2212x1672px — 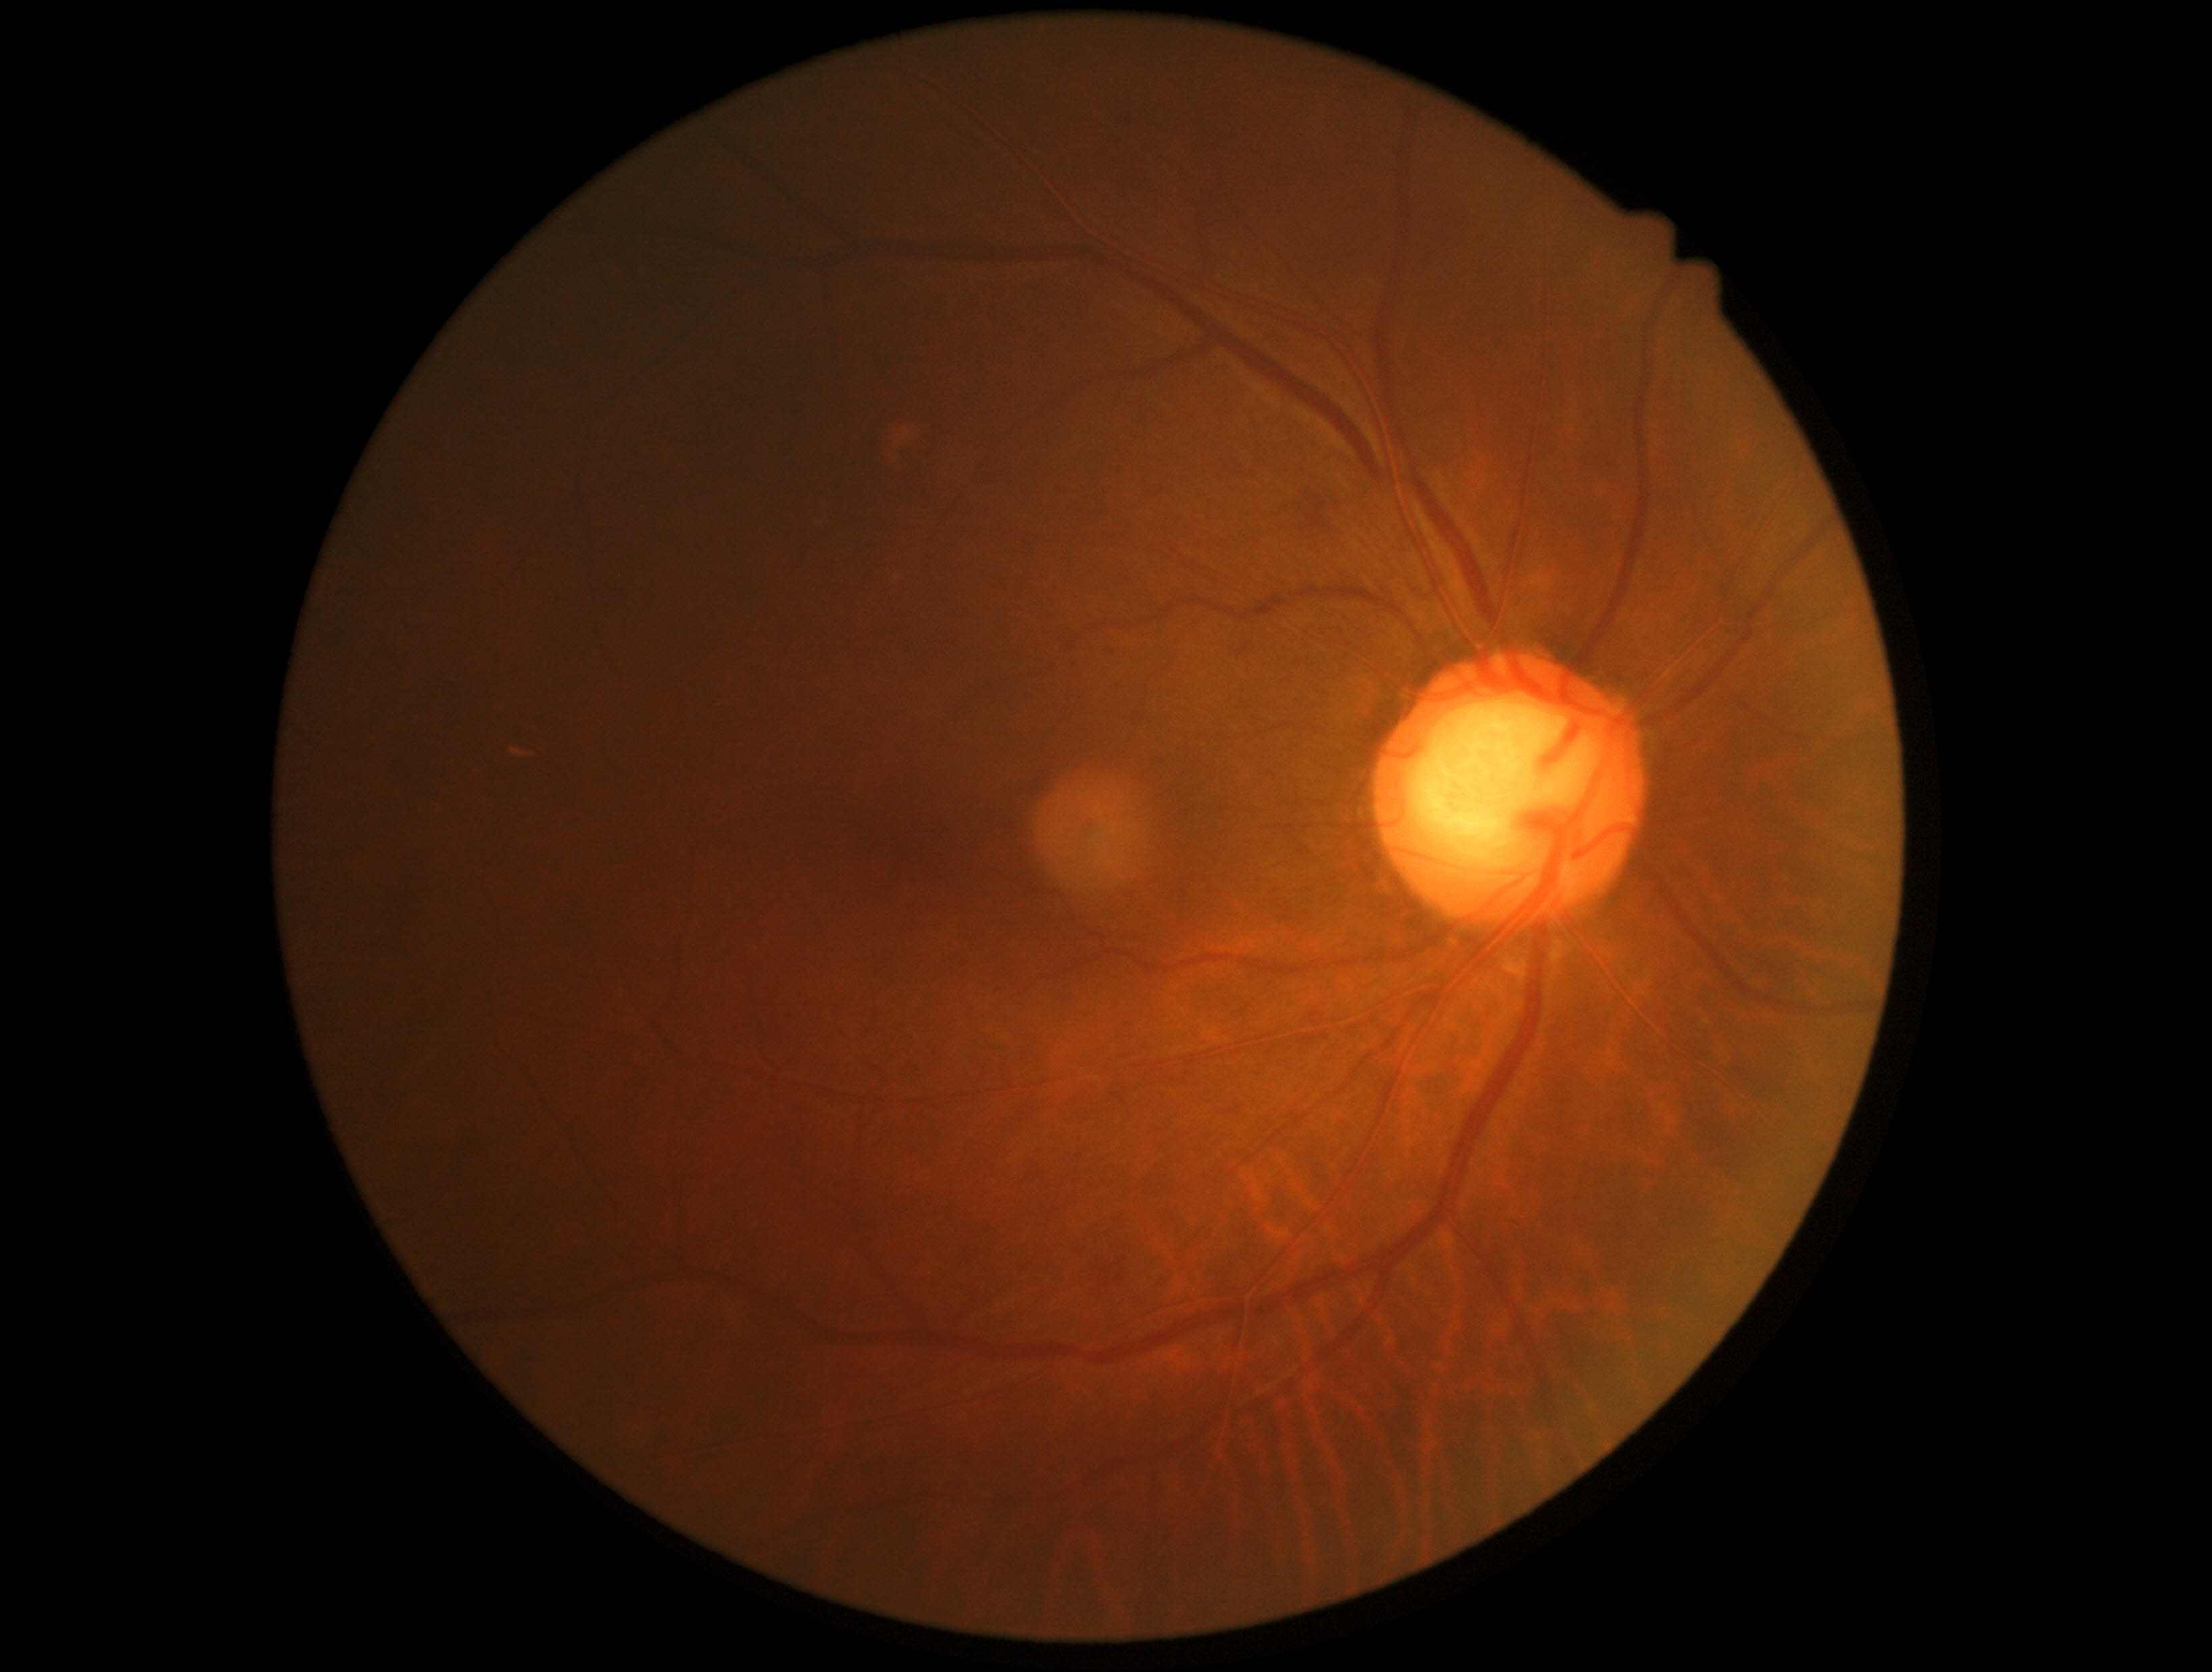

DR stage: grade 2 (moderate NPDR).
DR class: non-proliferative diabetic retinopathy.